Camera: NIDEK AFC-230. FOV: 45 degrees: 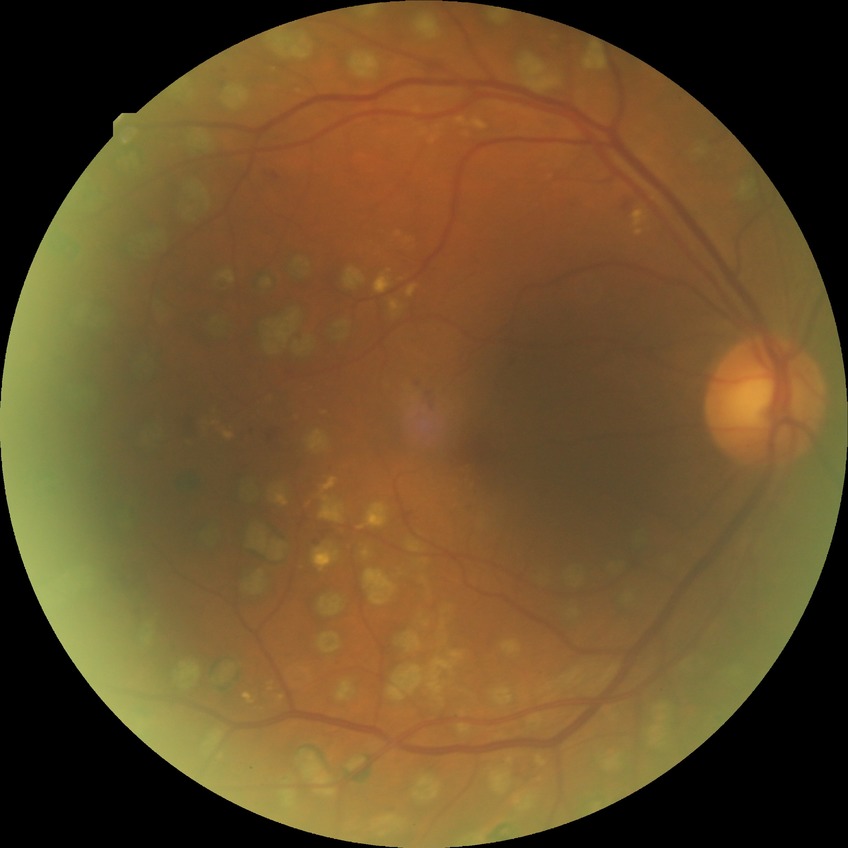

diabetic retinopathy (DR)=proliferative diabetic retinopathy (PDR).